45-degree field of view; image size 2352x1568:
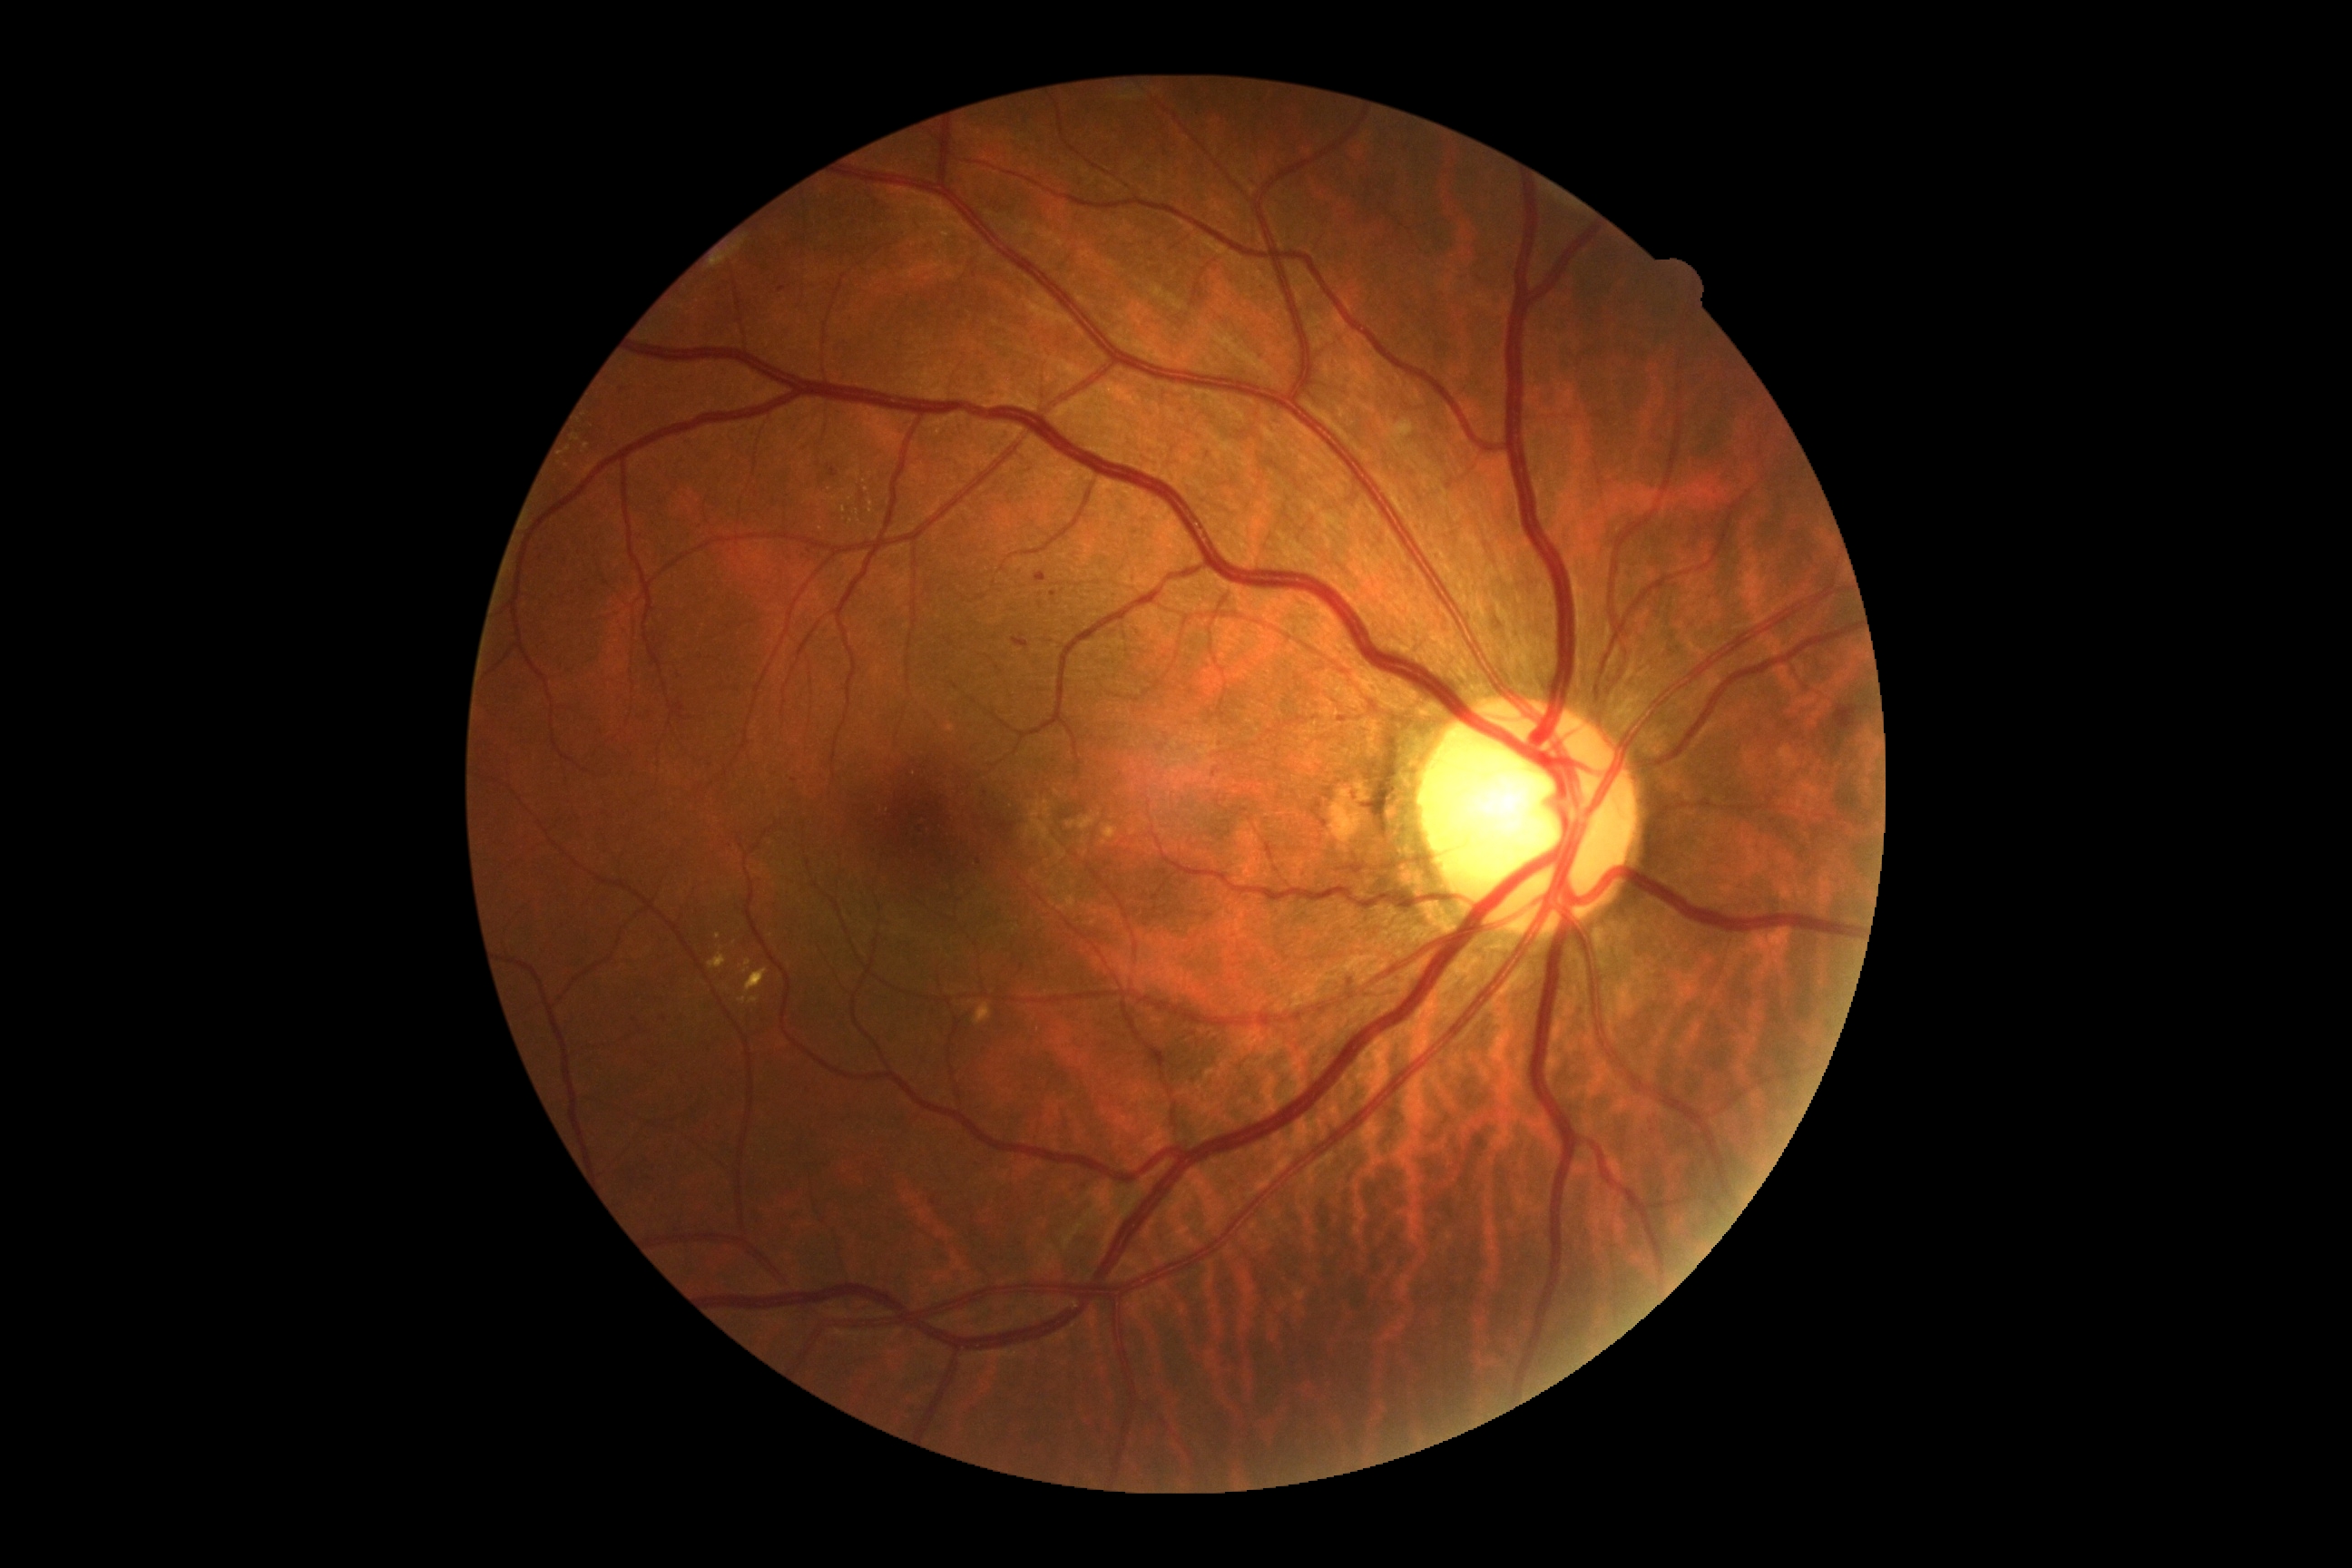 dr_grade: moderate NPDR (2)